130° field of view (Clarity RetCam 3). Wide-field fundus photograph from neonatal ROP screening: 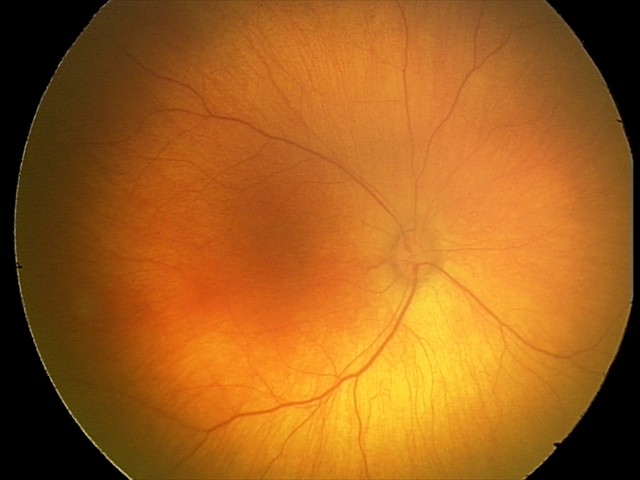

Physiological retinal appearance for postconceptual age.